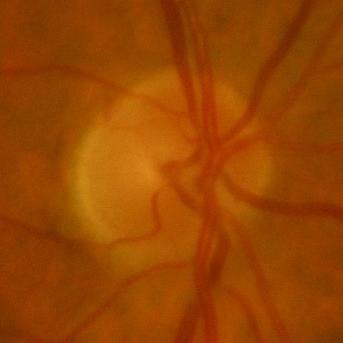
Glaucoma status: no glaucomatous findings.